45-degree field of view.
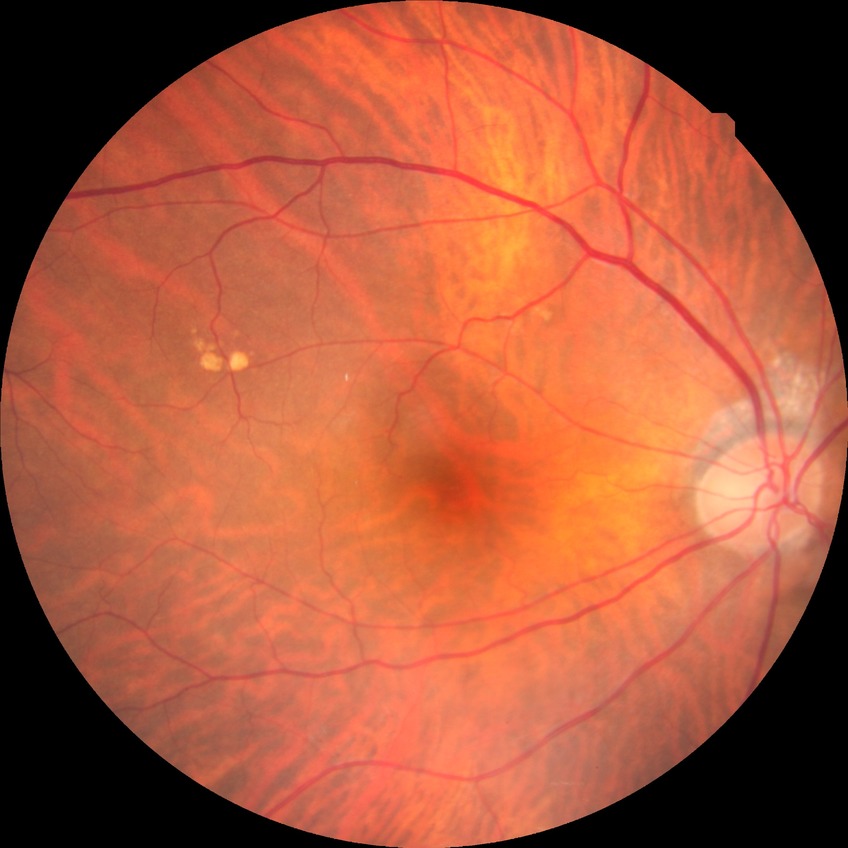
Diabetic retinopathy (DR) is no diabetic retinopathy (NDR).